UWF retinal mosaic.
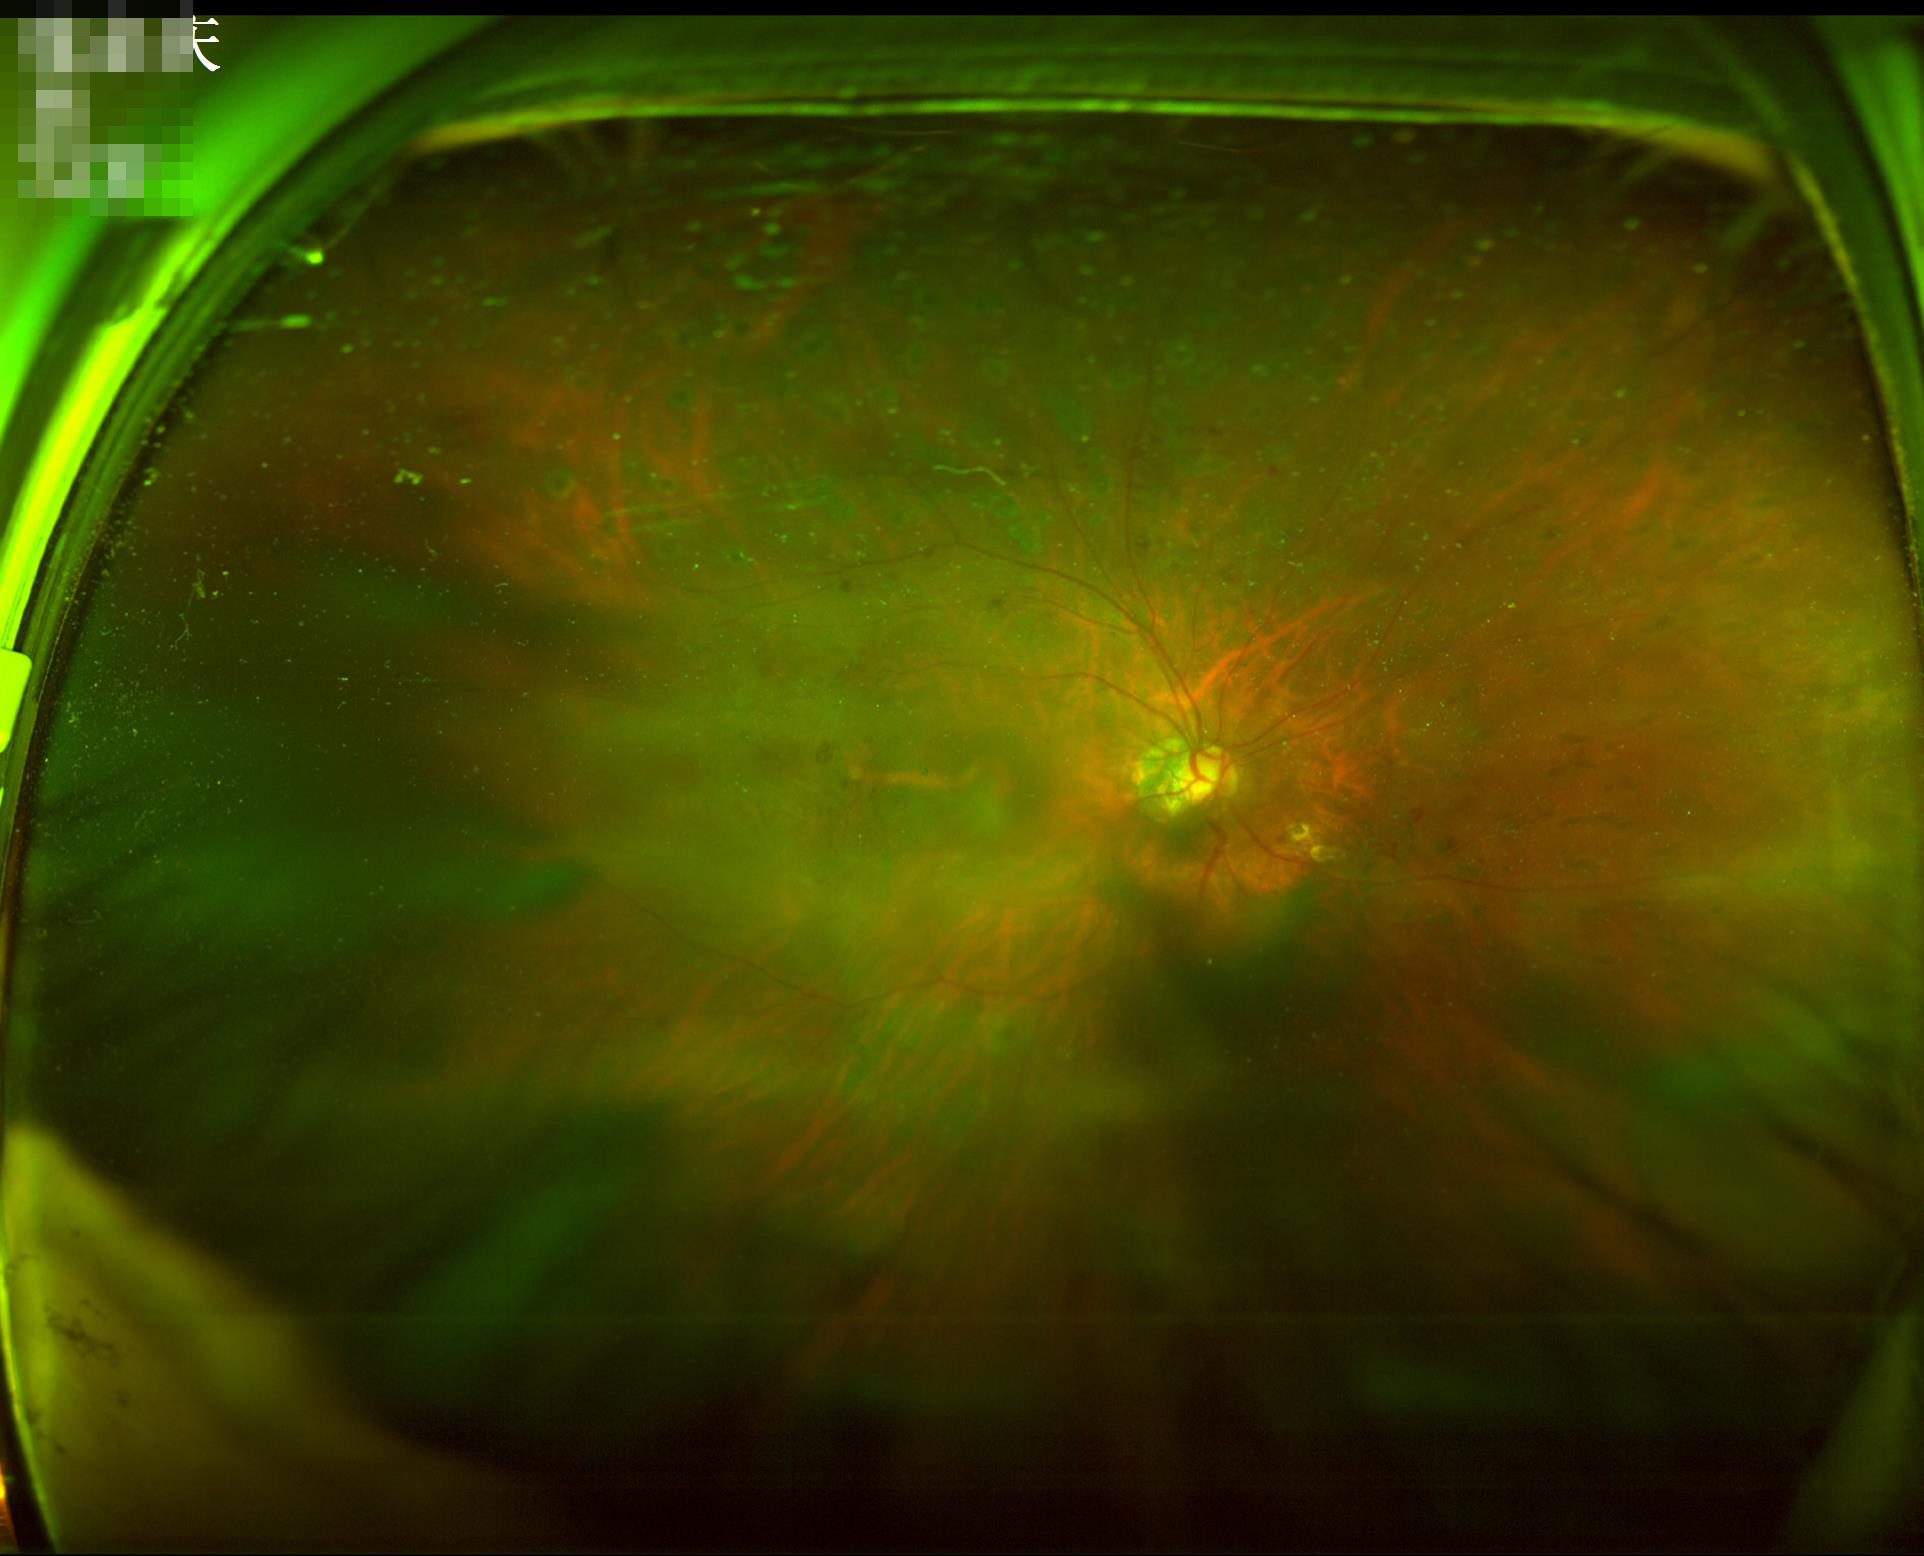 Adequate contrast for distinguishing structures.
Poor illumination with uneven exposure.
Out of focus; structures are indistinct.
Image quality is suboptimal.